Acquired with a NIDEK AFC-230 · DR severity per modified Davis staging — 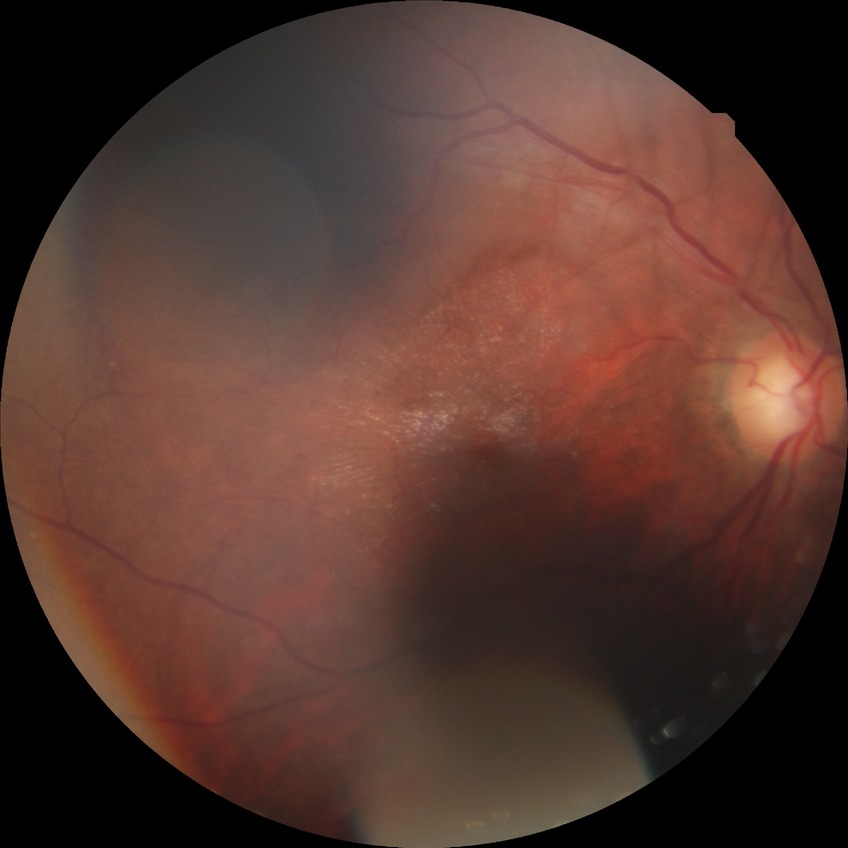 Diabetic retinopathy (DR): simple diabetic retinopathy (SDR).
The retinopathy is classified as non-proliferative diabetic retinopathy.